Topcon TRC fundus camera; optic nerve head photograph: 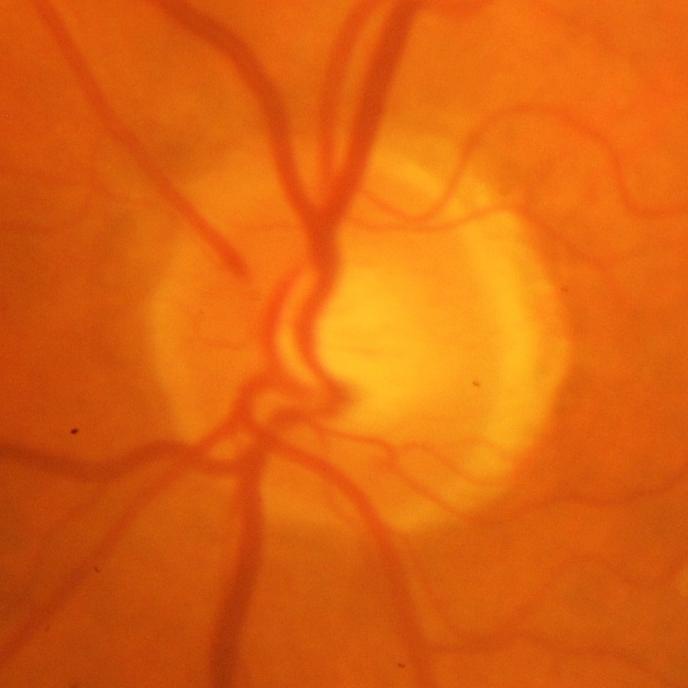
The image shows glaucoma.